Diabetic retinopathy graded by the modified Davis classification; FOV: 45 degrees: 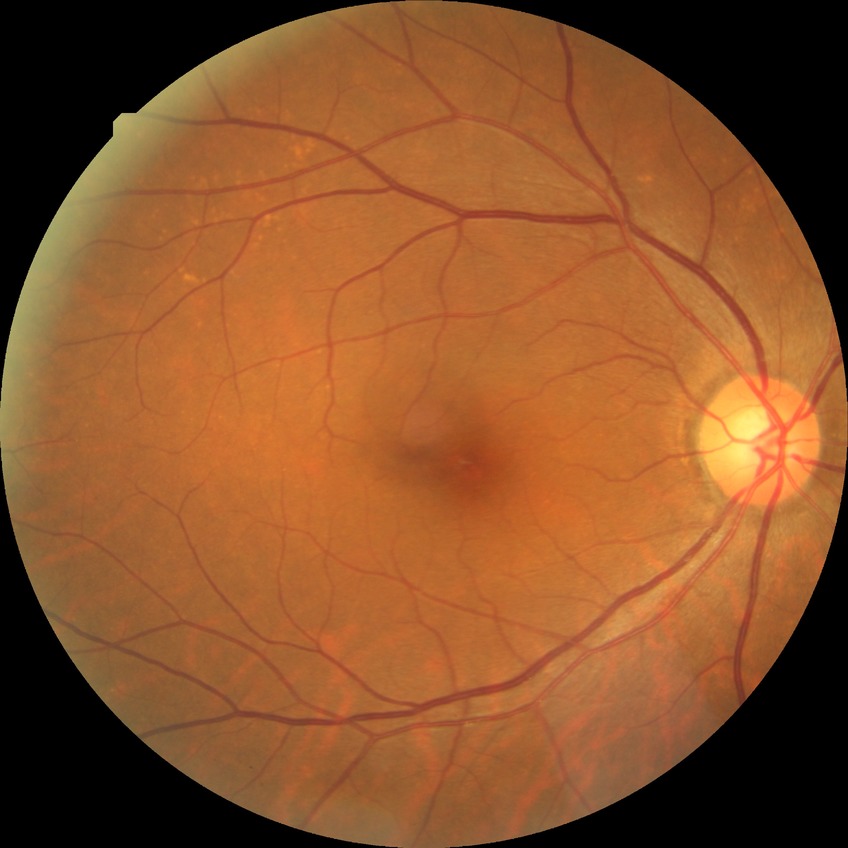 diabetic retinopathy (DR) = NDR (no diabetic retinopathy).